45 degree fundus photograph · 848 by 848 pixels · modified Davis grading — 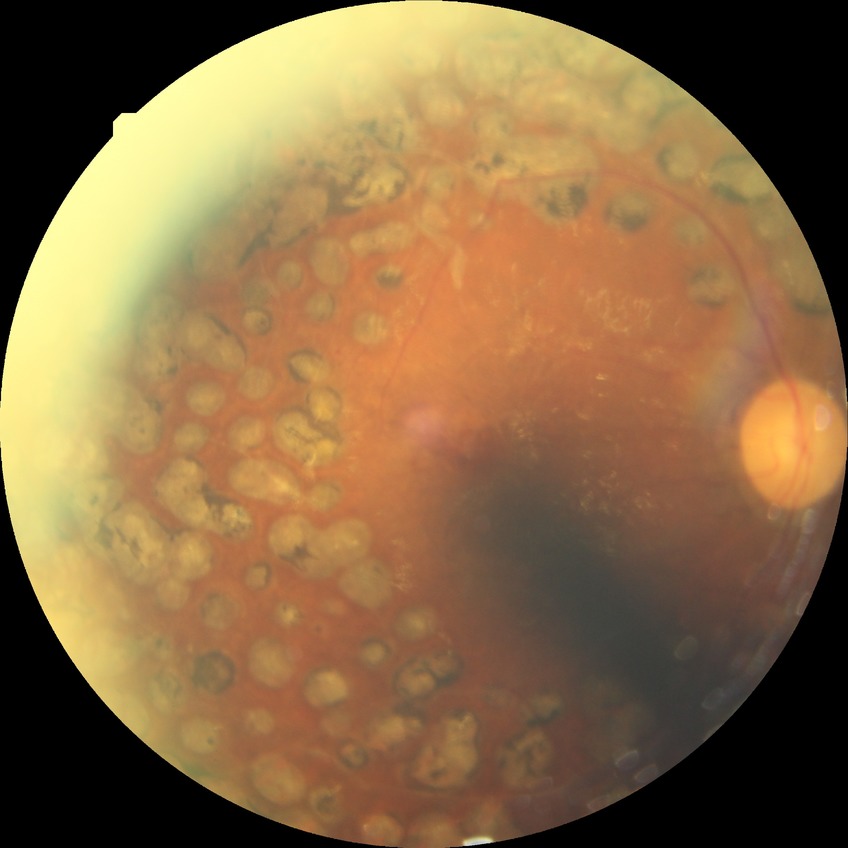 Findings:
* diabetic retinopathy (DR): proliferative diabetic retinopathy (PDR)